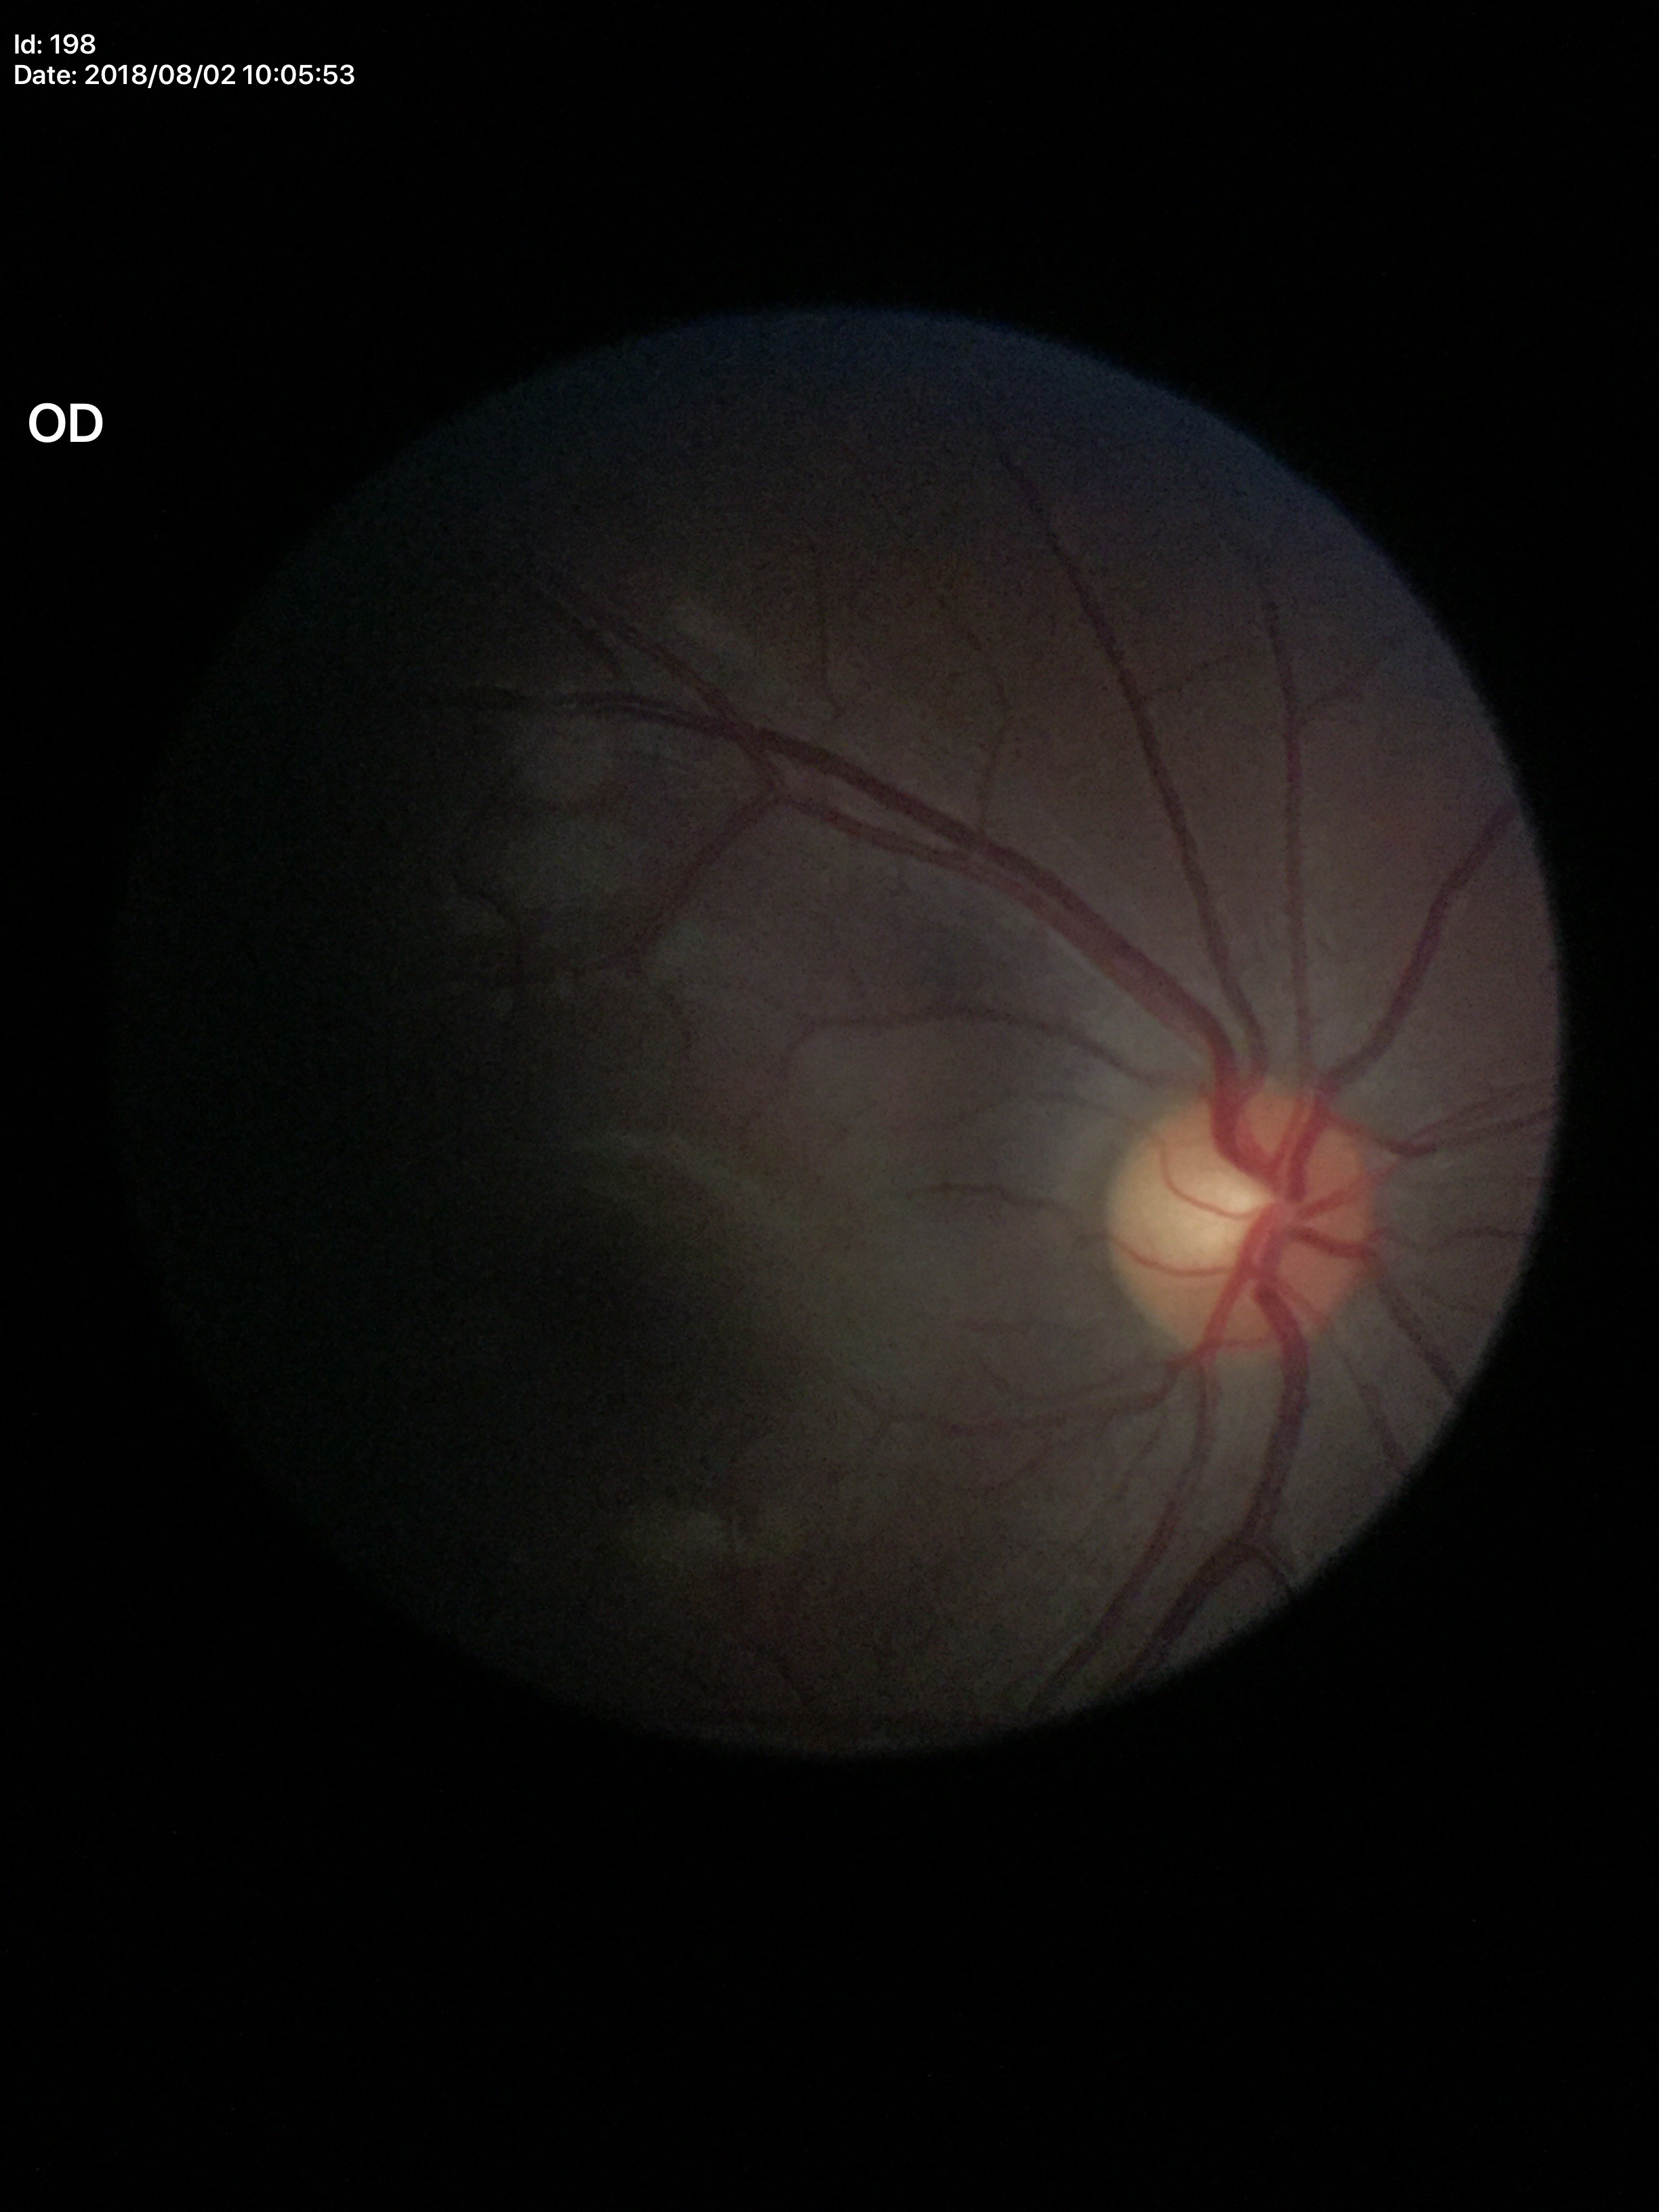
Q: Vertical CDR?
A: 0.48
Q: Is there glaucoma suspicion?
A: no suspicious findings (all 5 graders called normal)